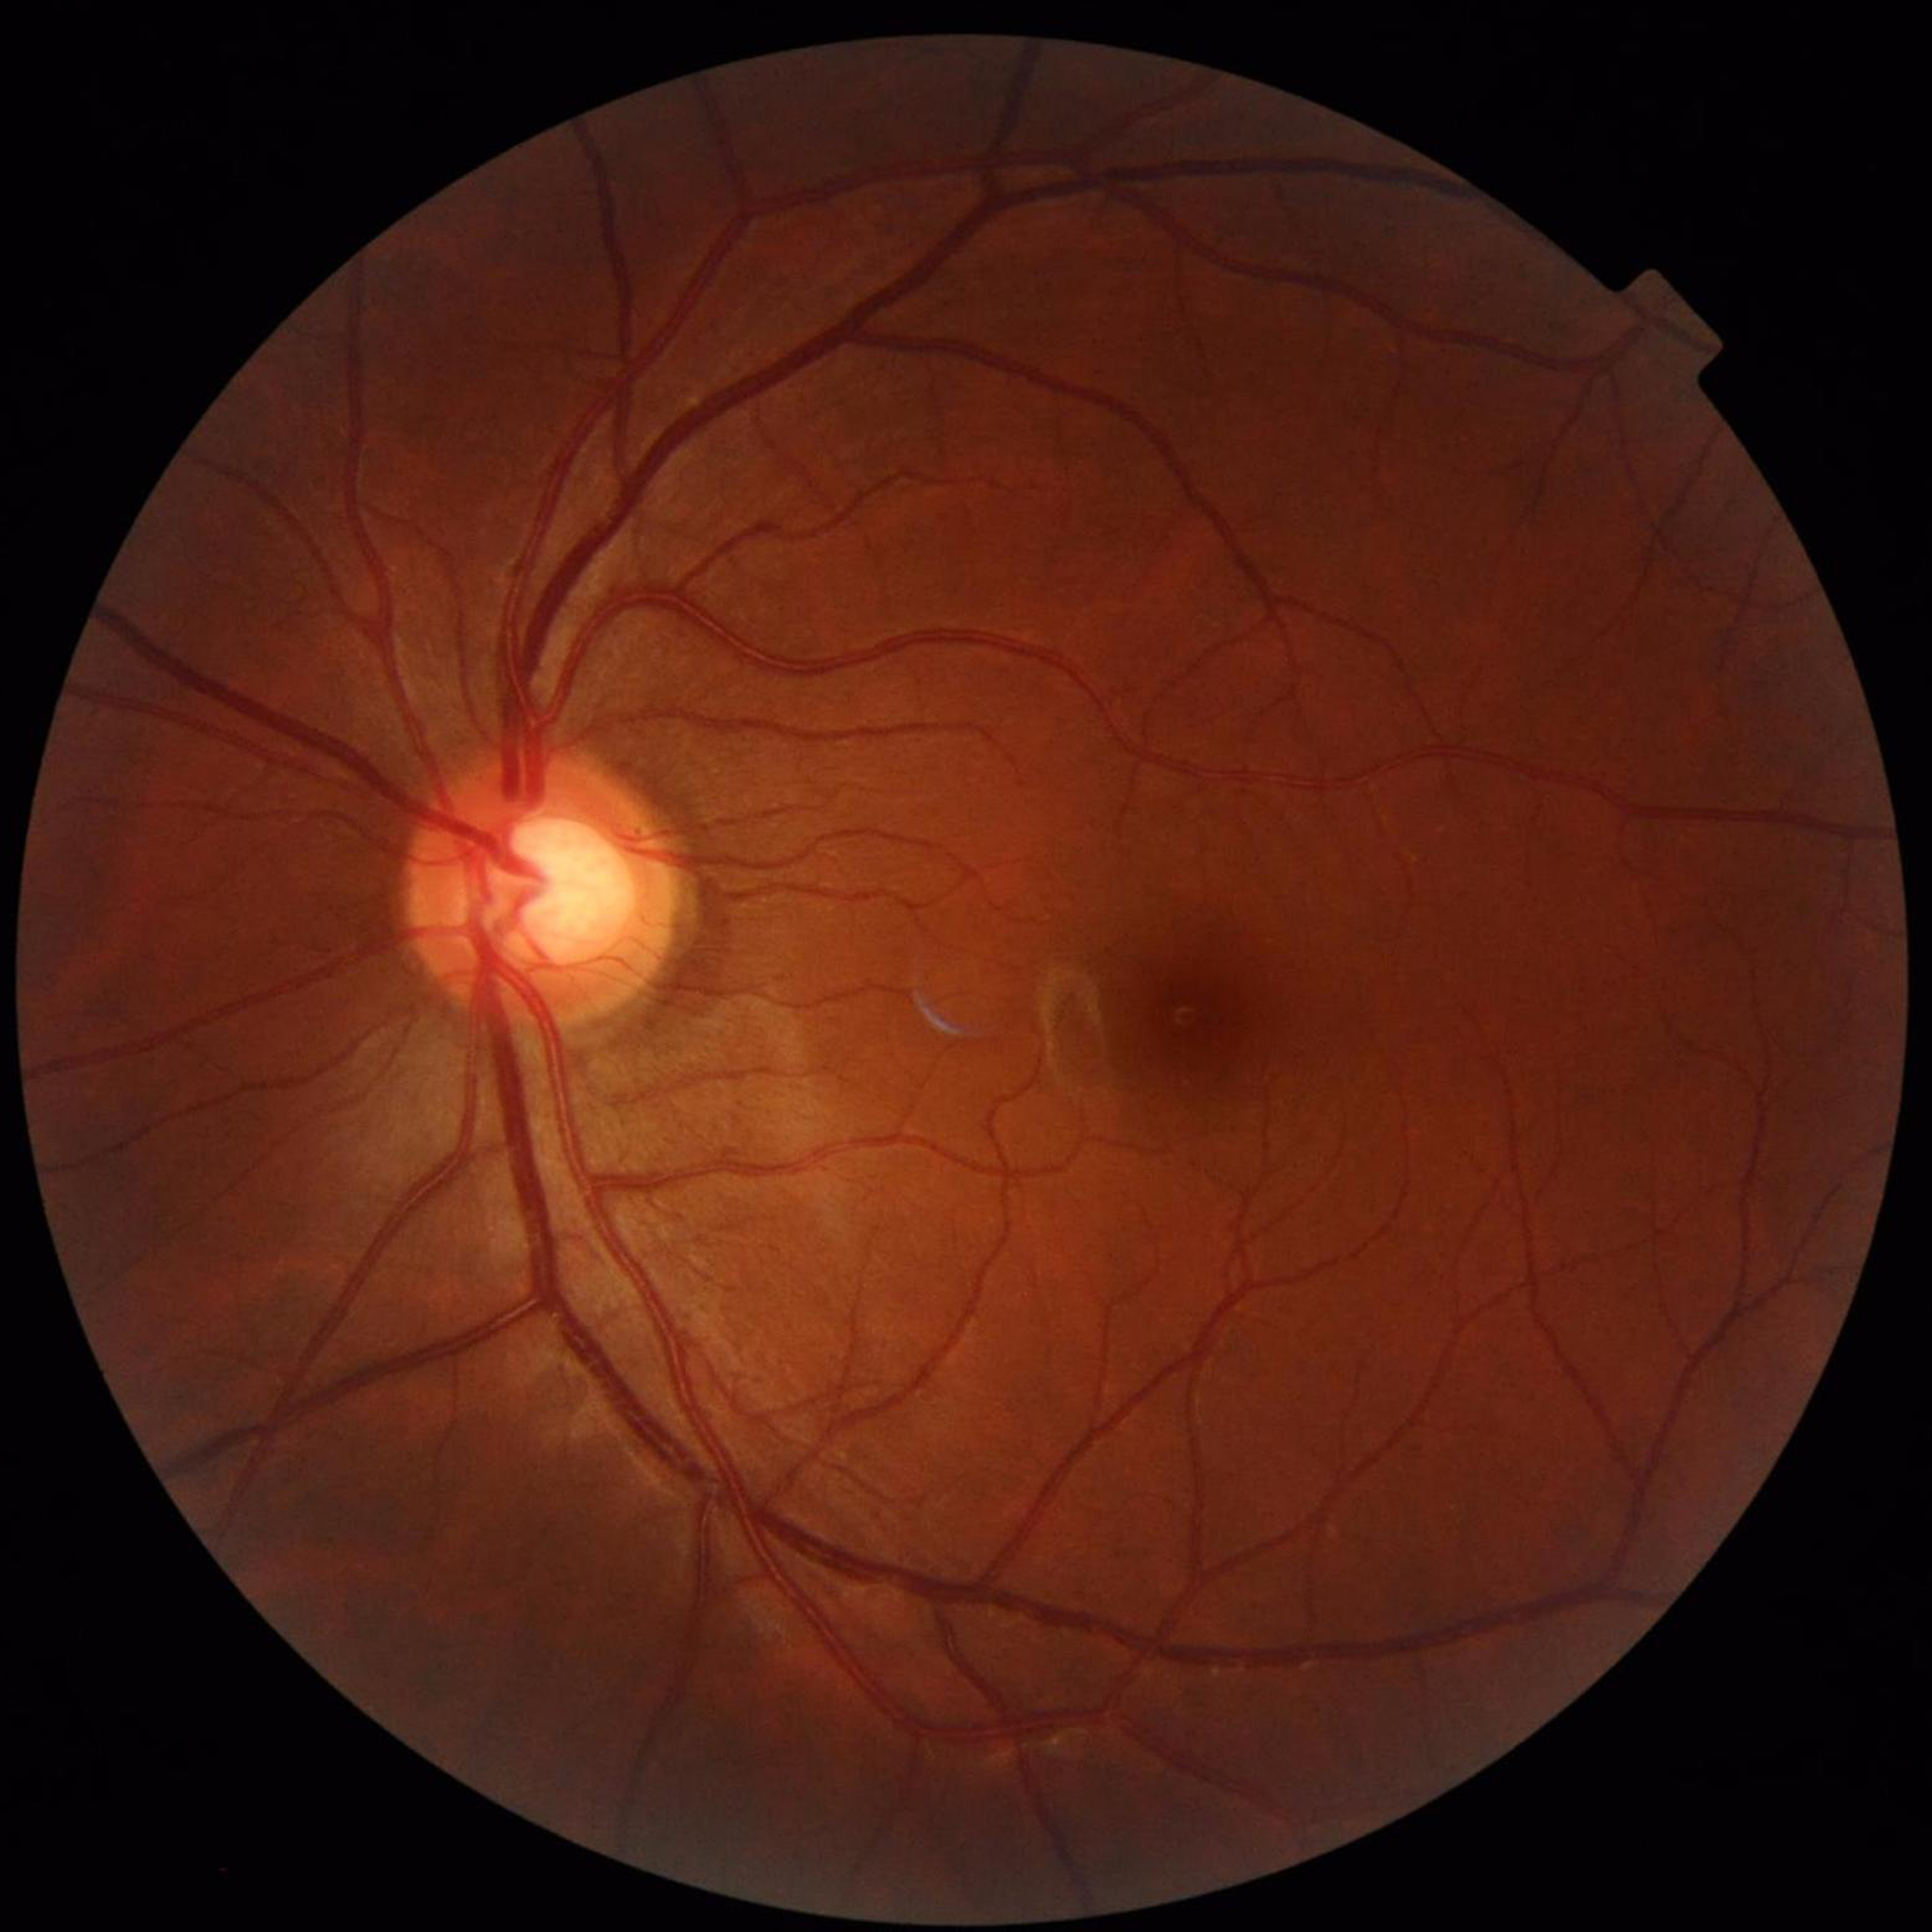

Color fundus photograph from a patient diagnosed with glaucoma.